Pediatric wide-field fundus photograph · 640x480 — 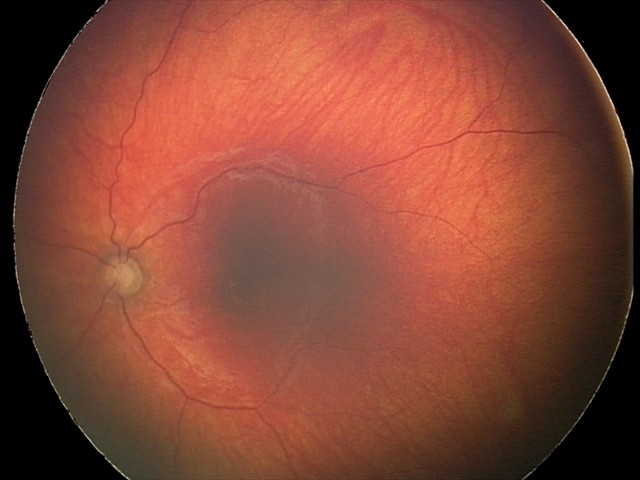
Finding: optic nerve hypoplasia.